45° field of view: 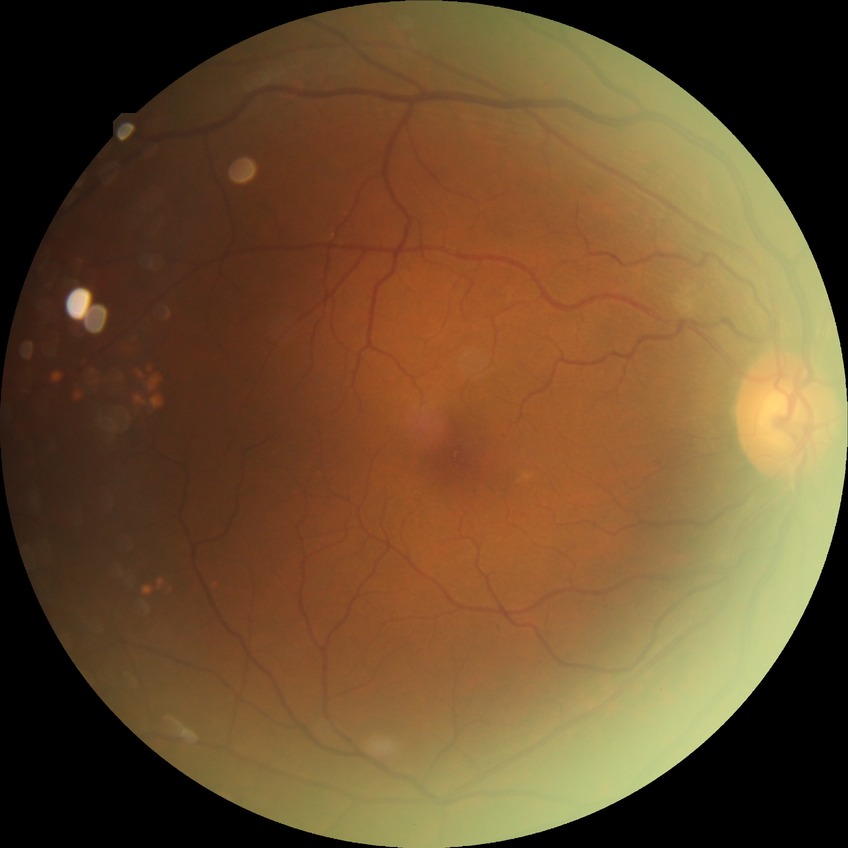

No diabetic retinal disease findings. Modified Davis grade is NDR.